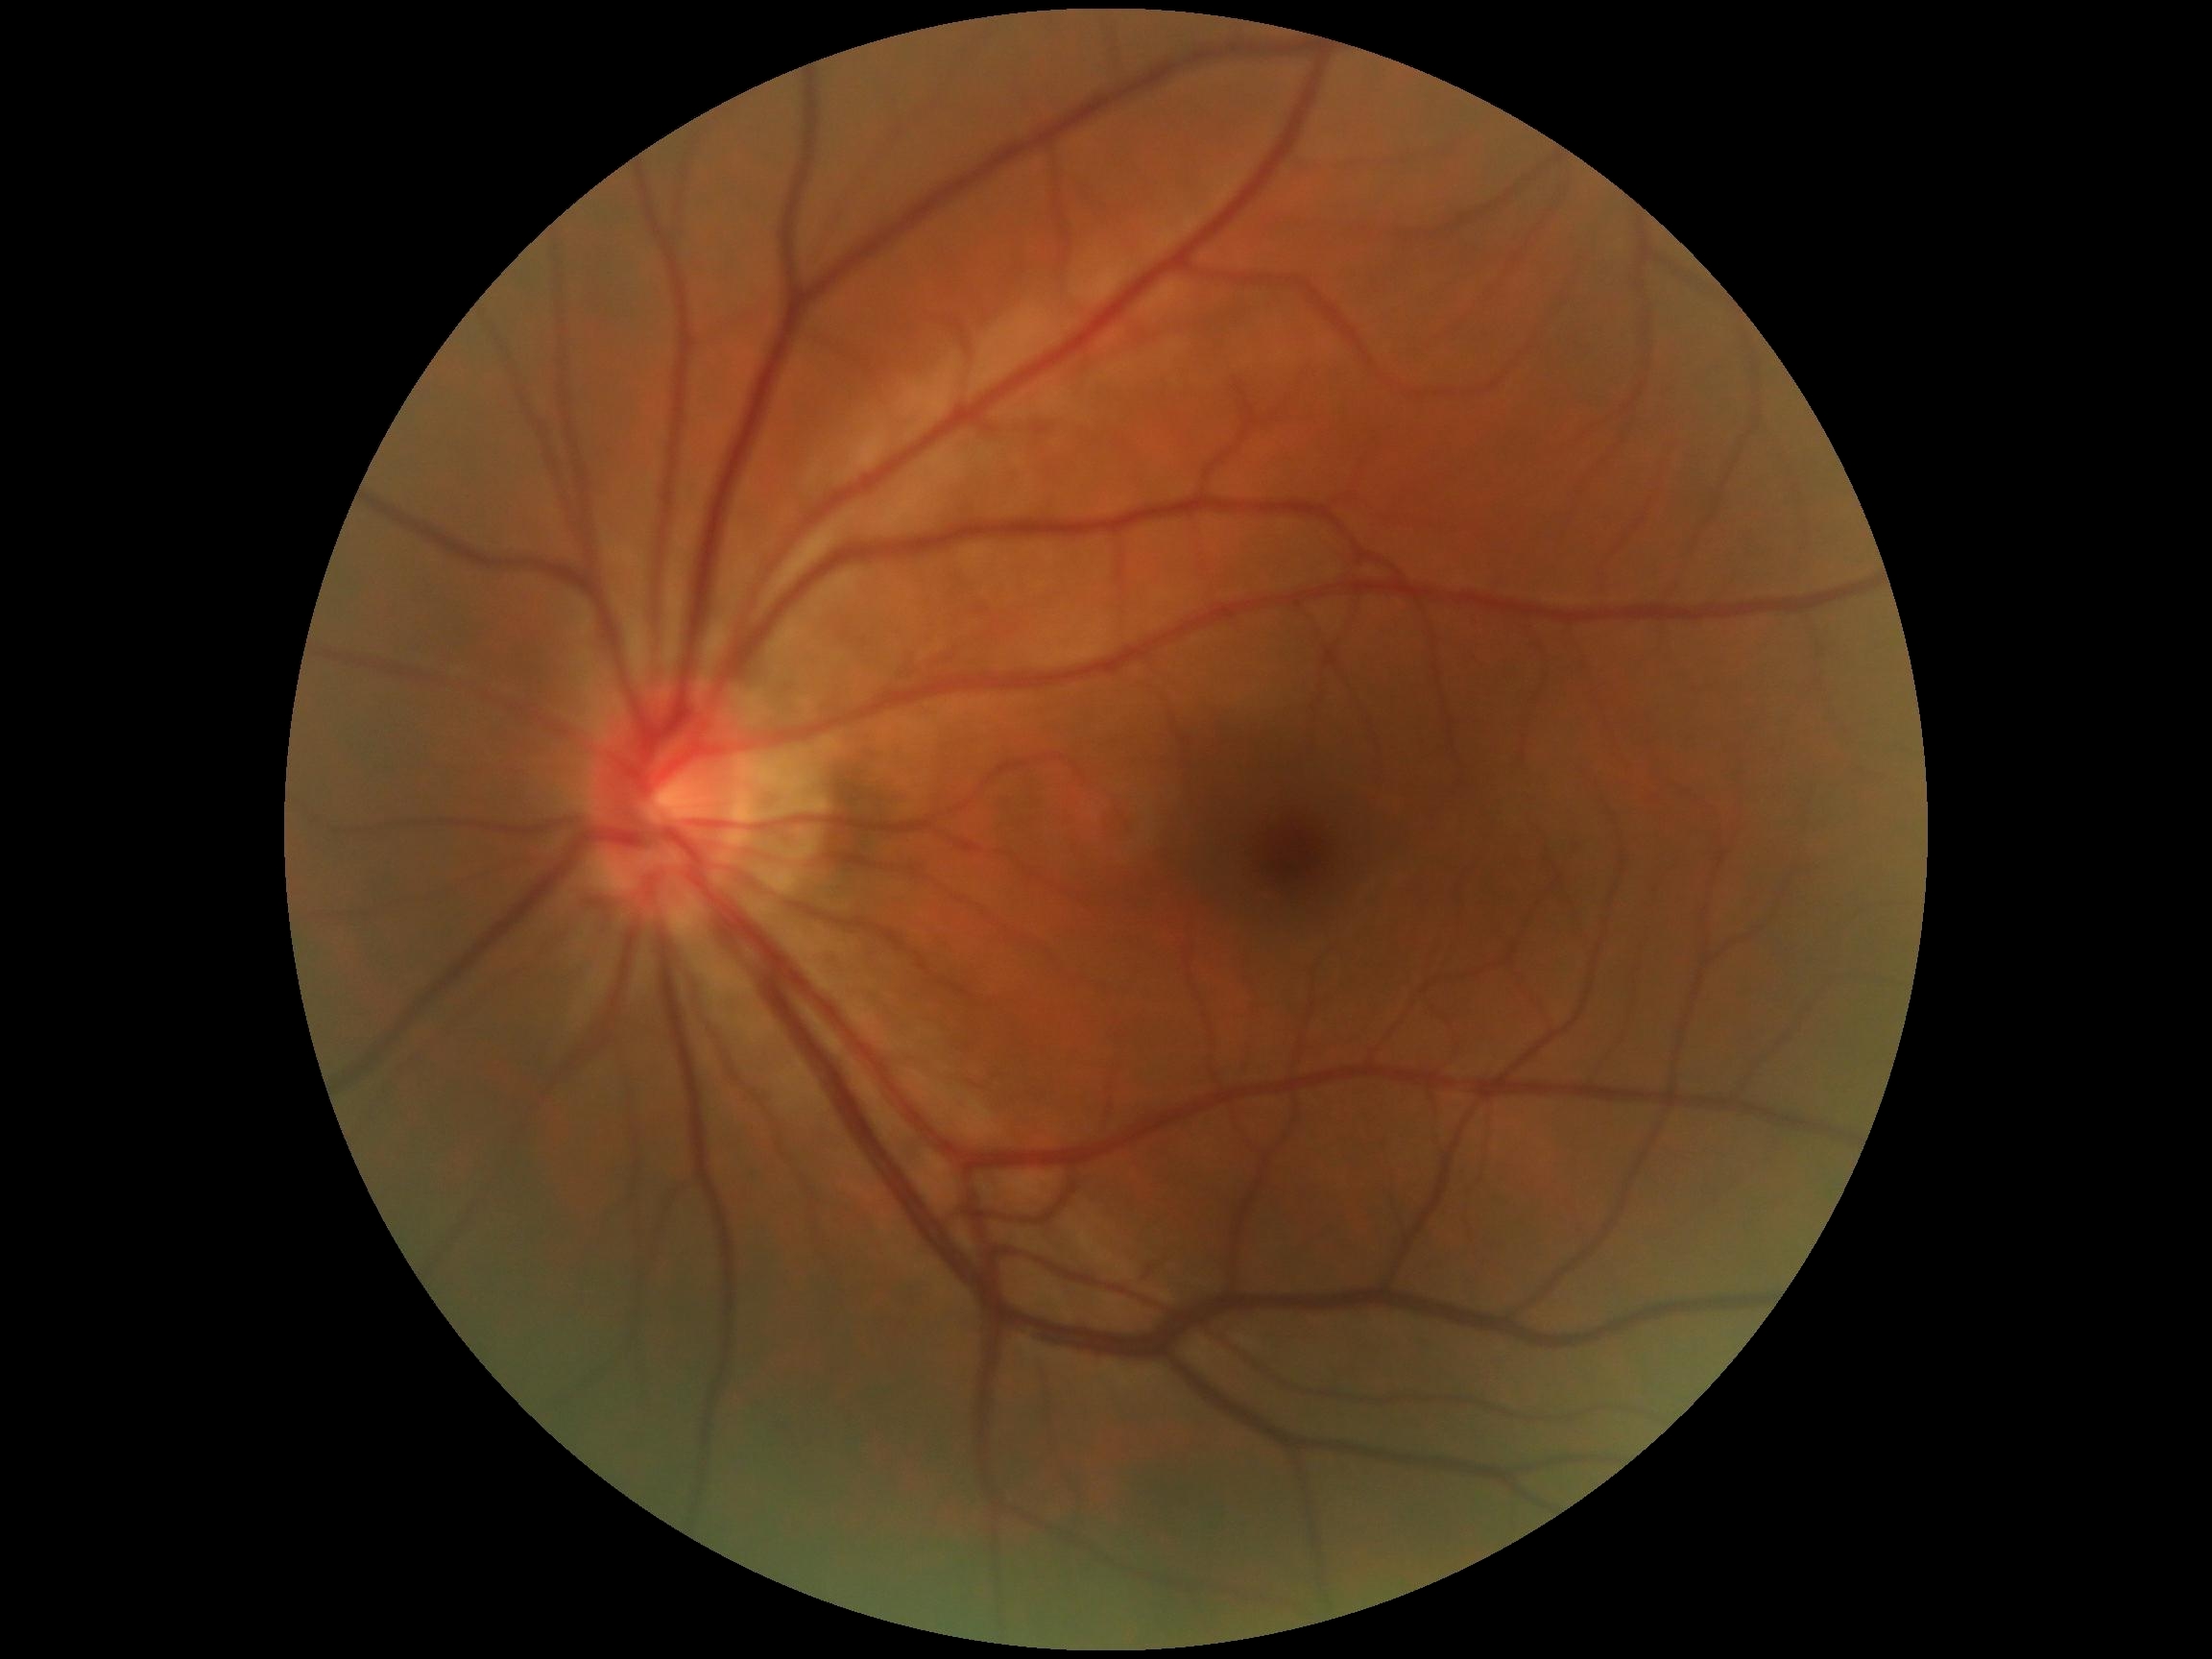

– DR severity — grade 0